CFP:
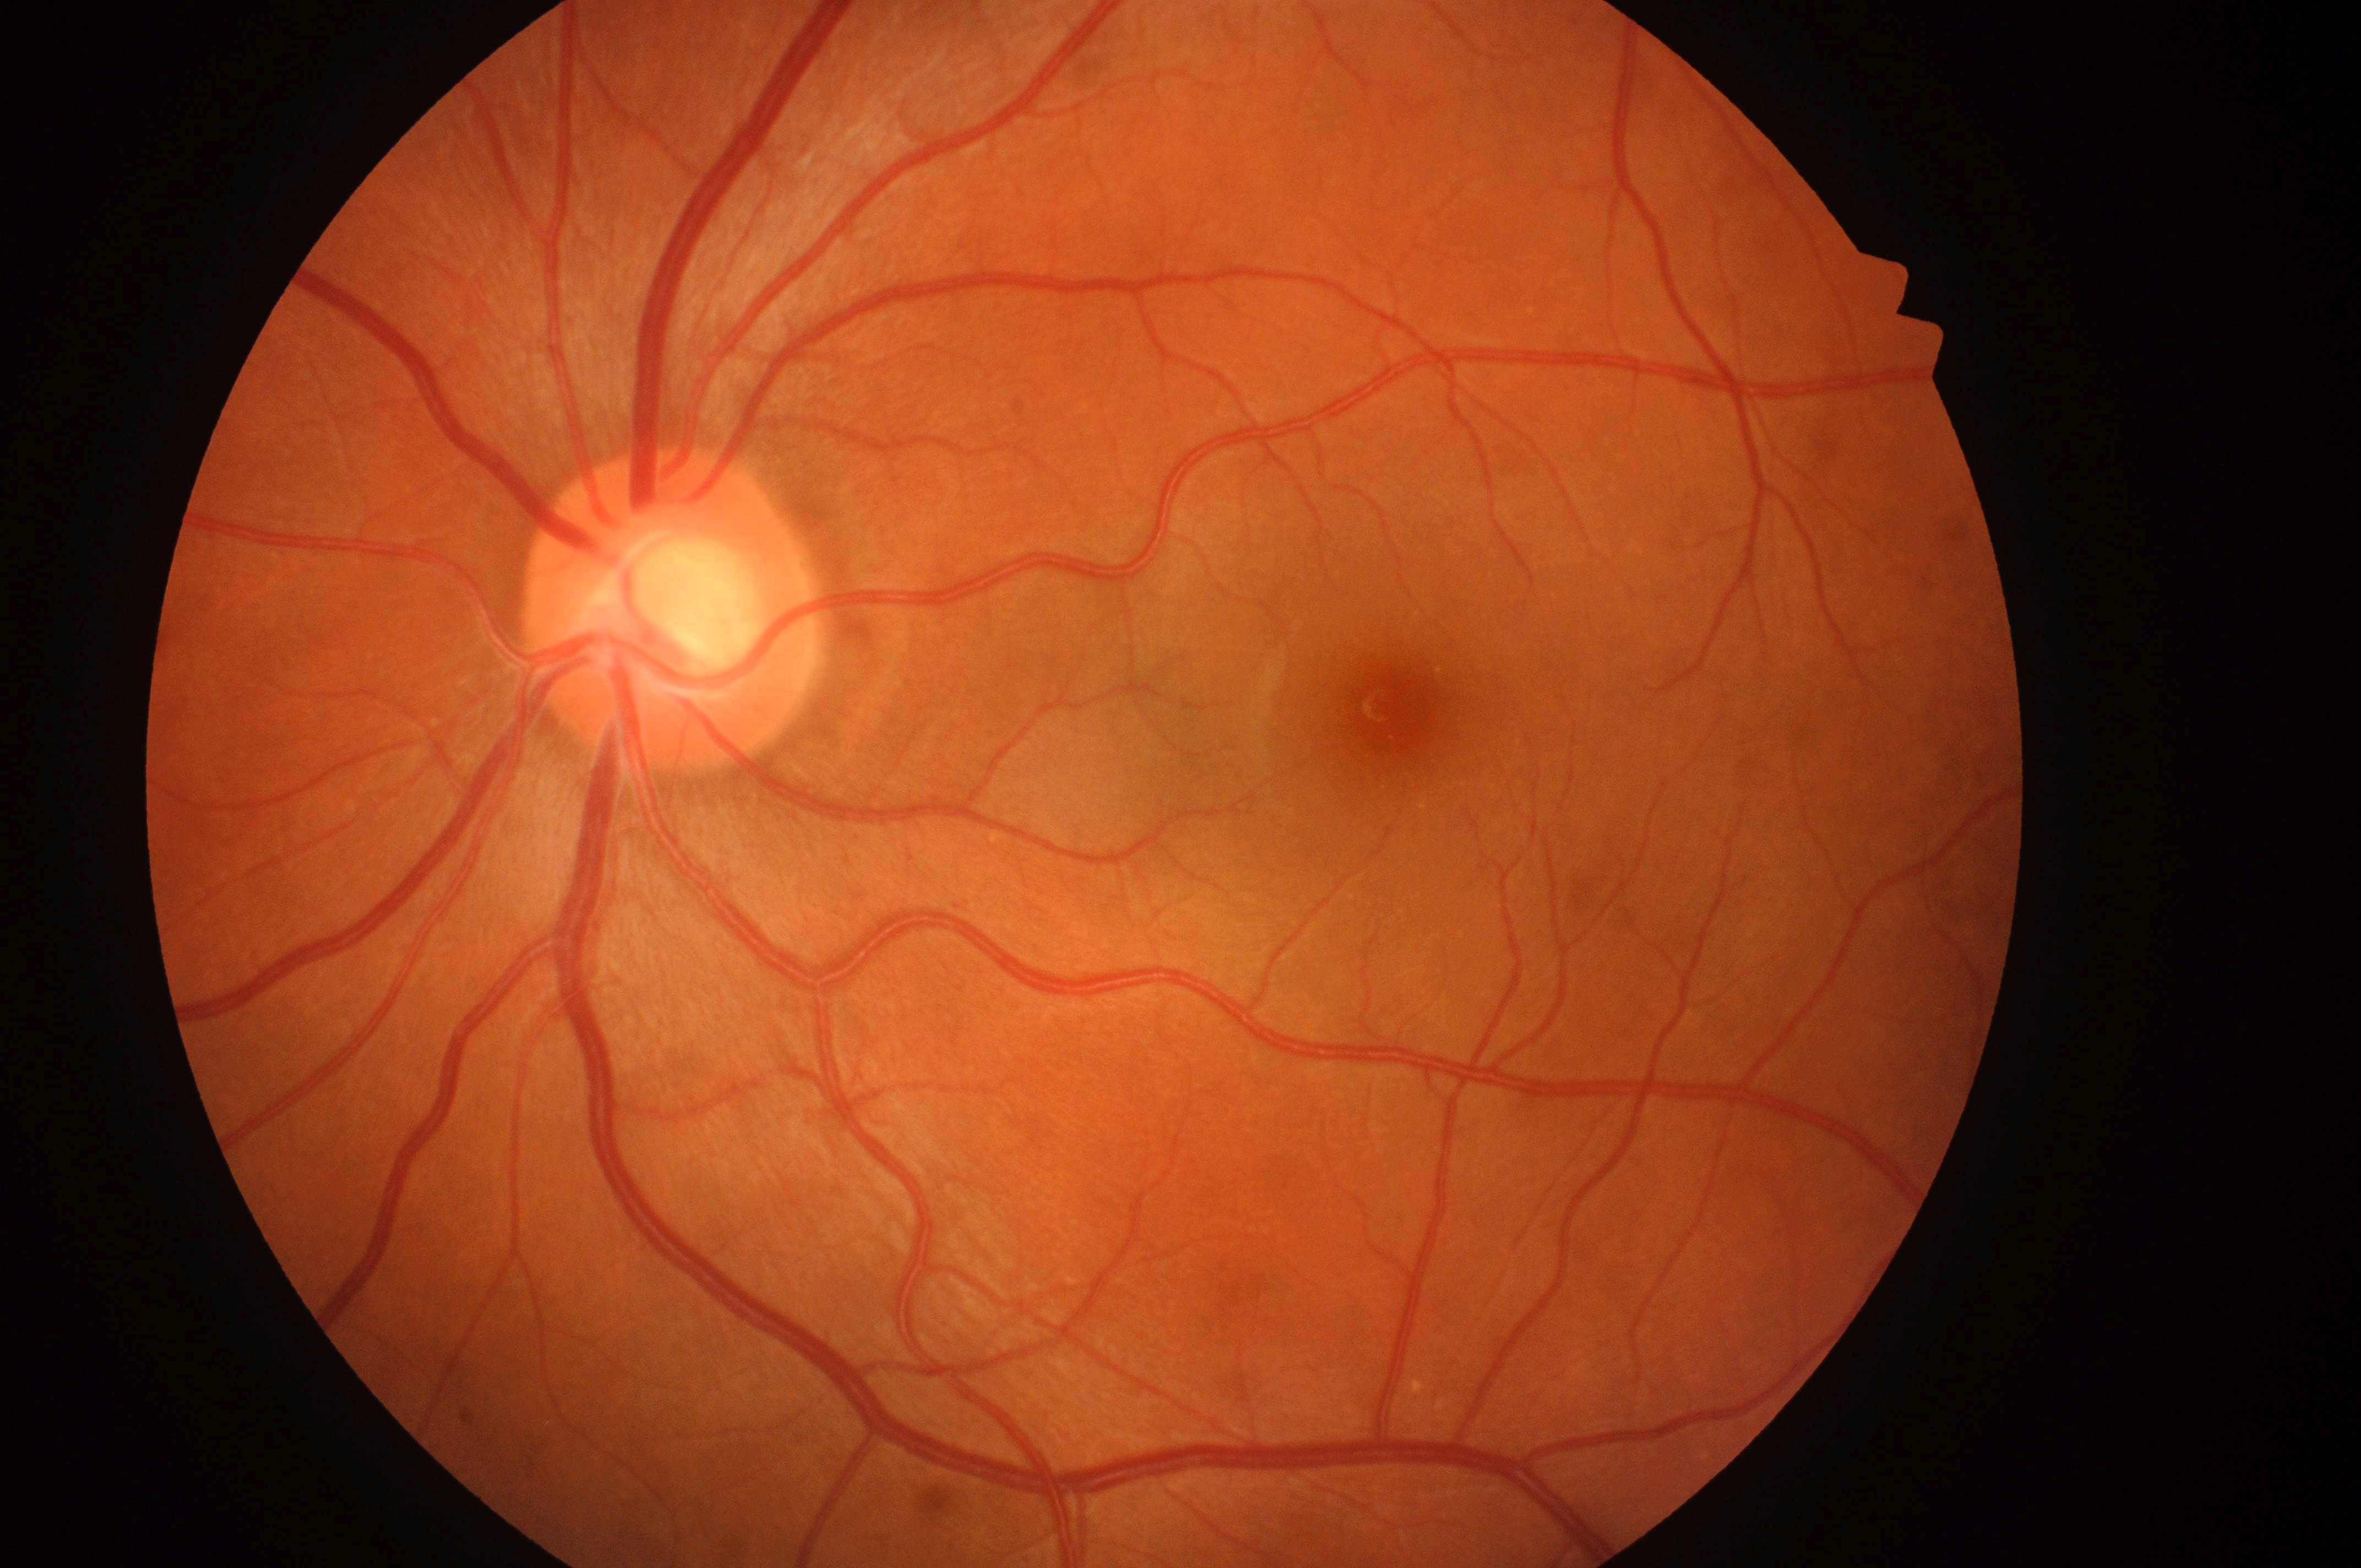 Retinopathy: grade 0 (no apparent retinopathy). No signs of diabetic retinopathy or diabetic macular edema. This is the OS. The disc center is at [664, 620]. The macular center is at [1399, 715]. Macular edema: no risk (grade 0).